Color fundus photograph:
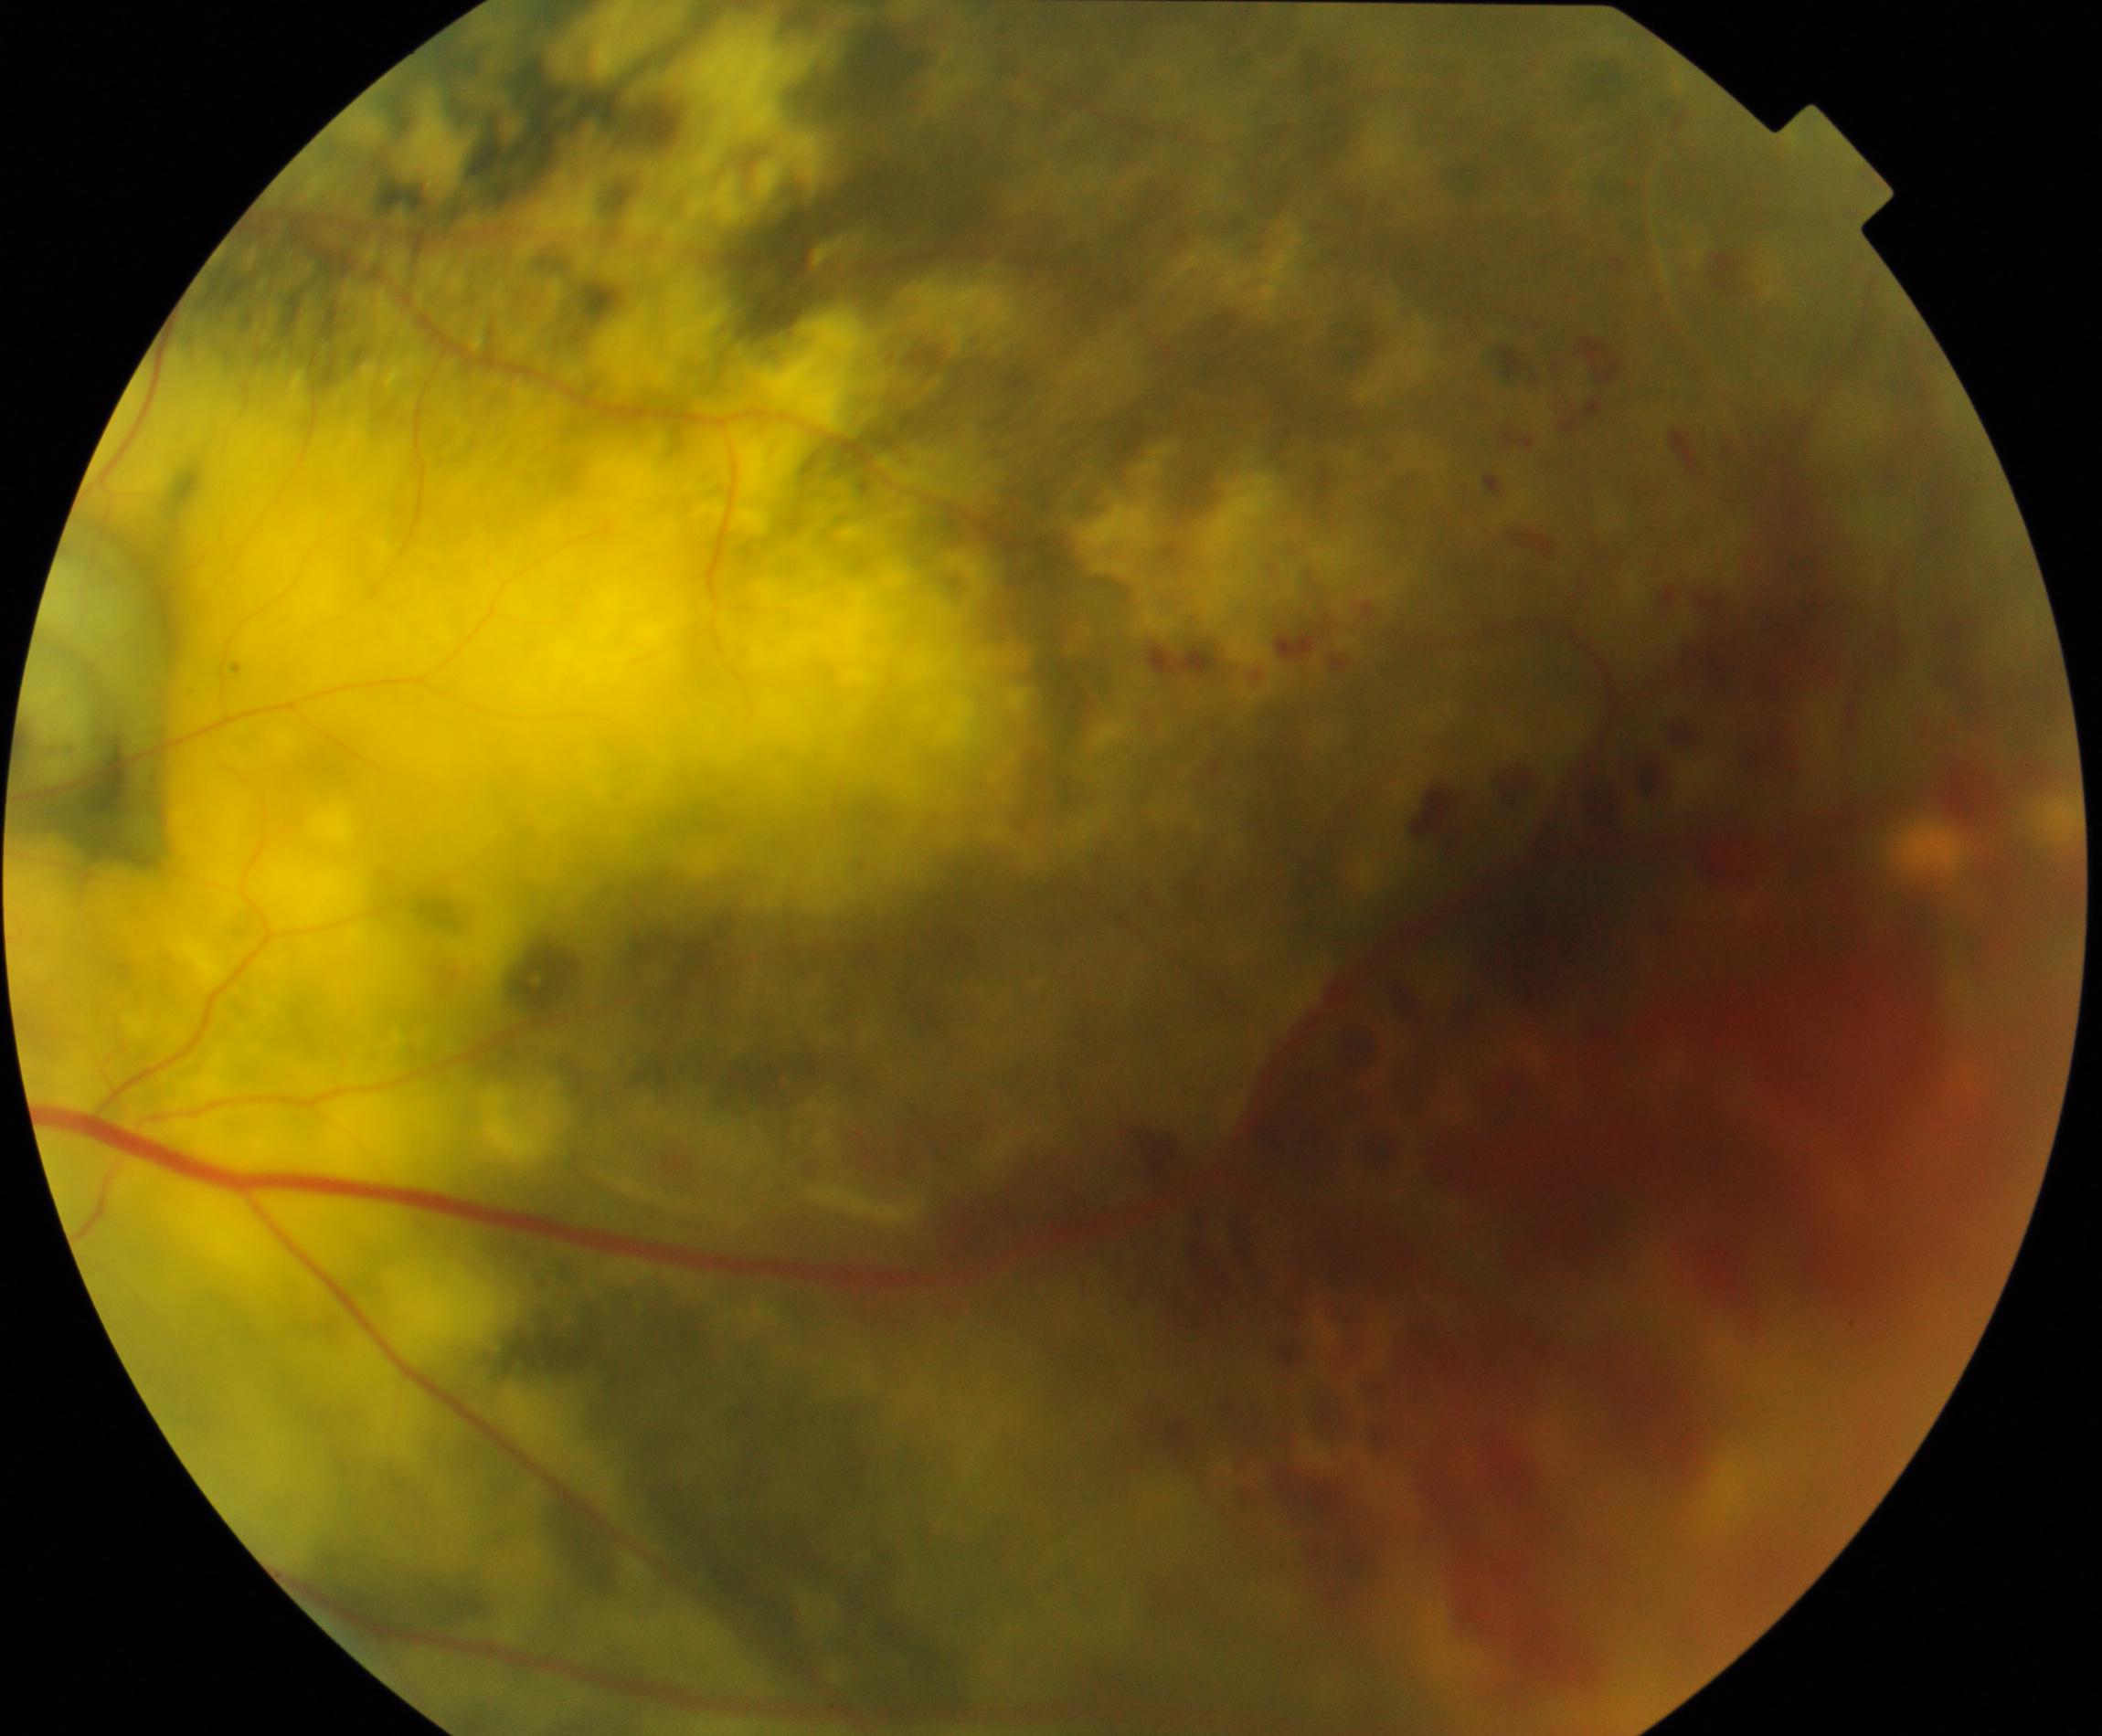

Diagnosis: massive hard exudates.